1932x1932px: 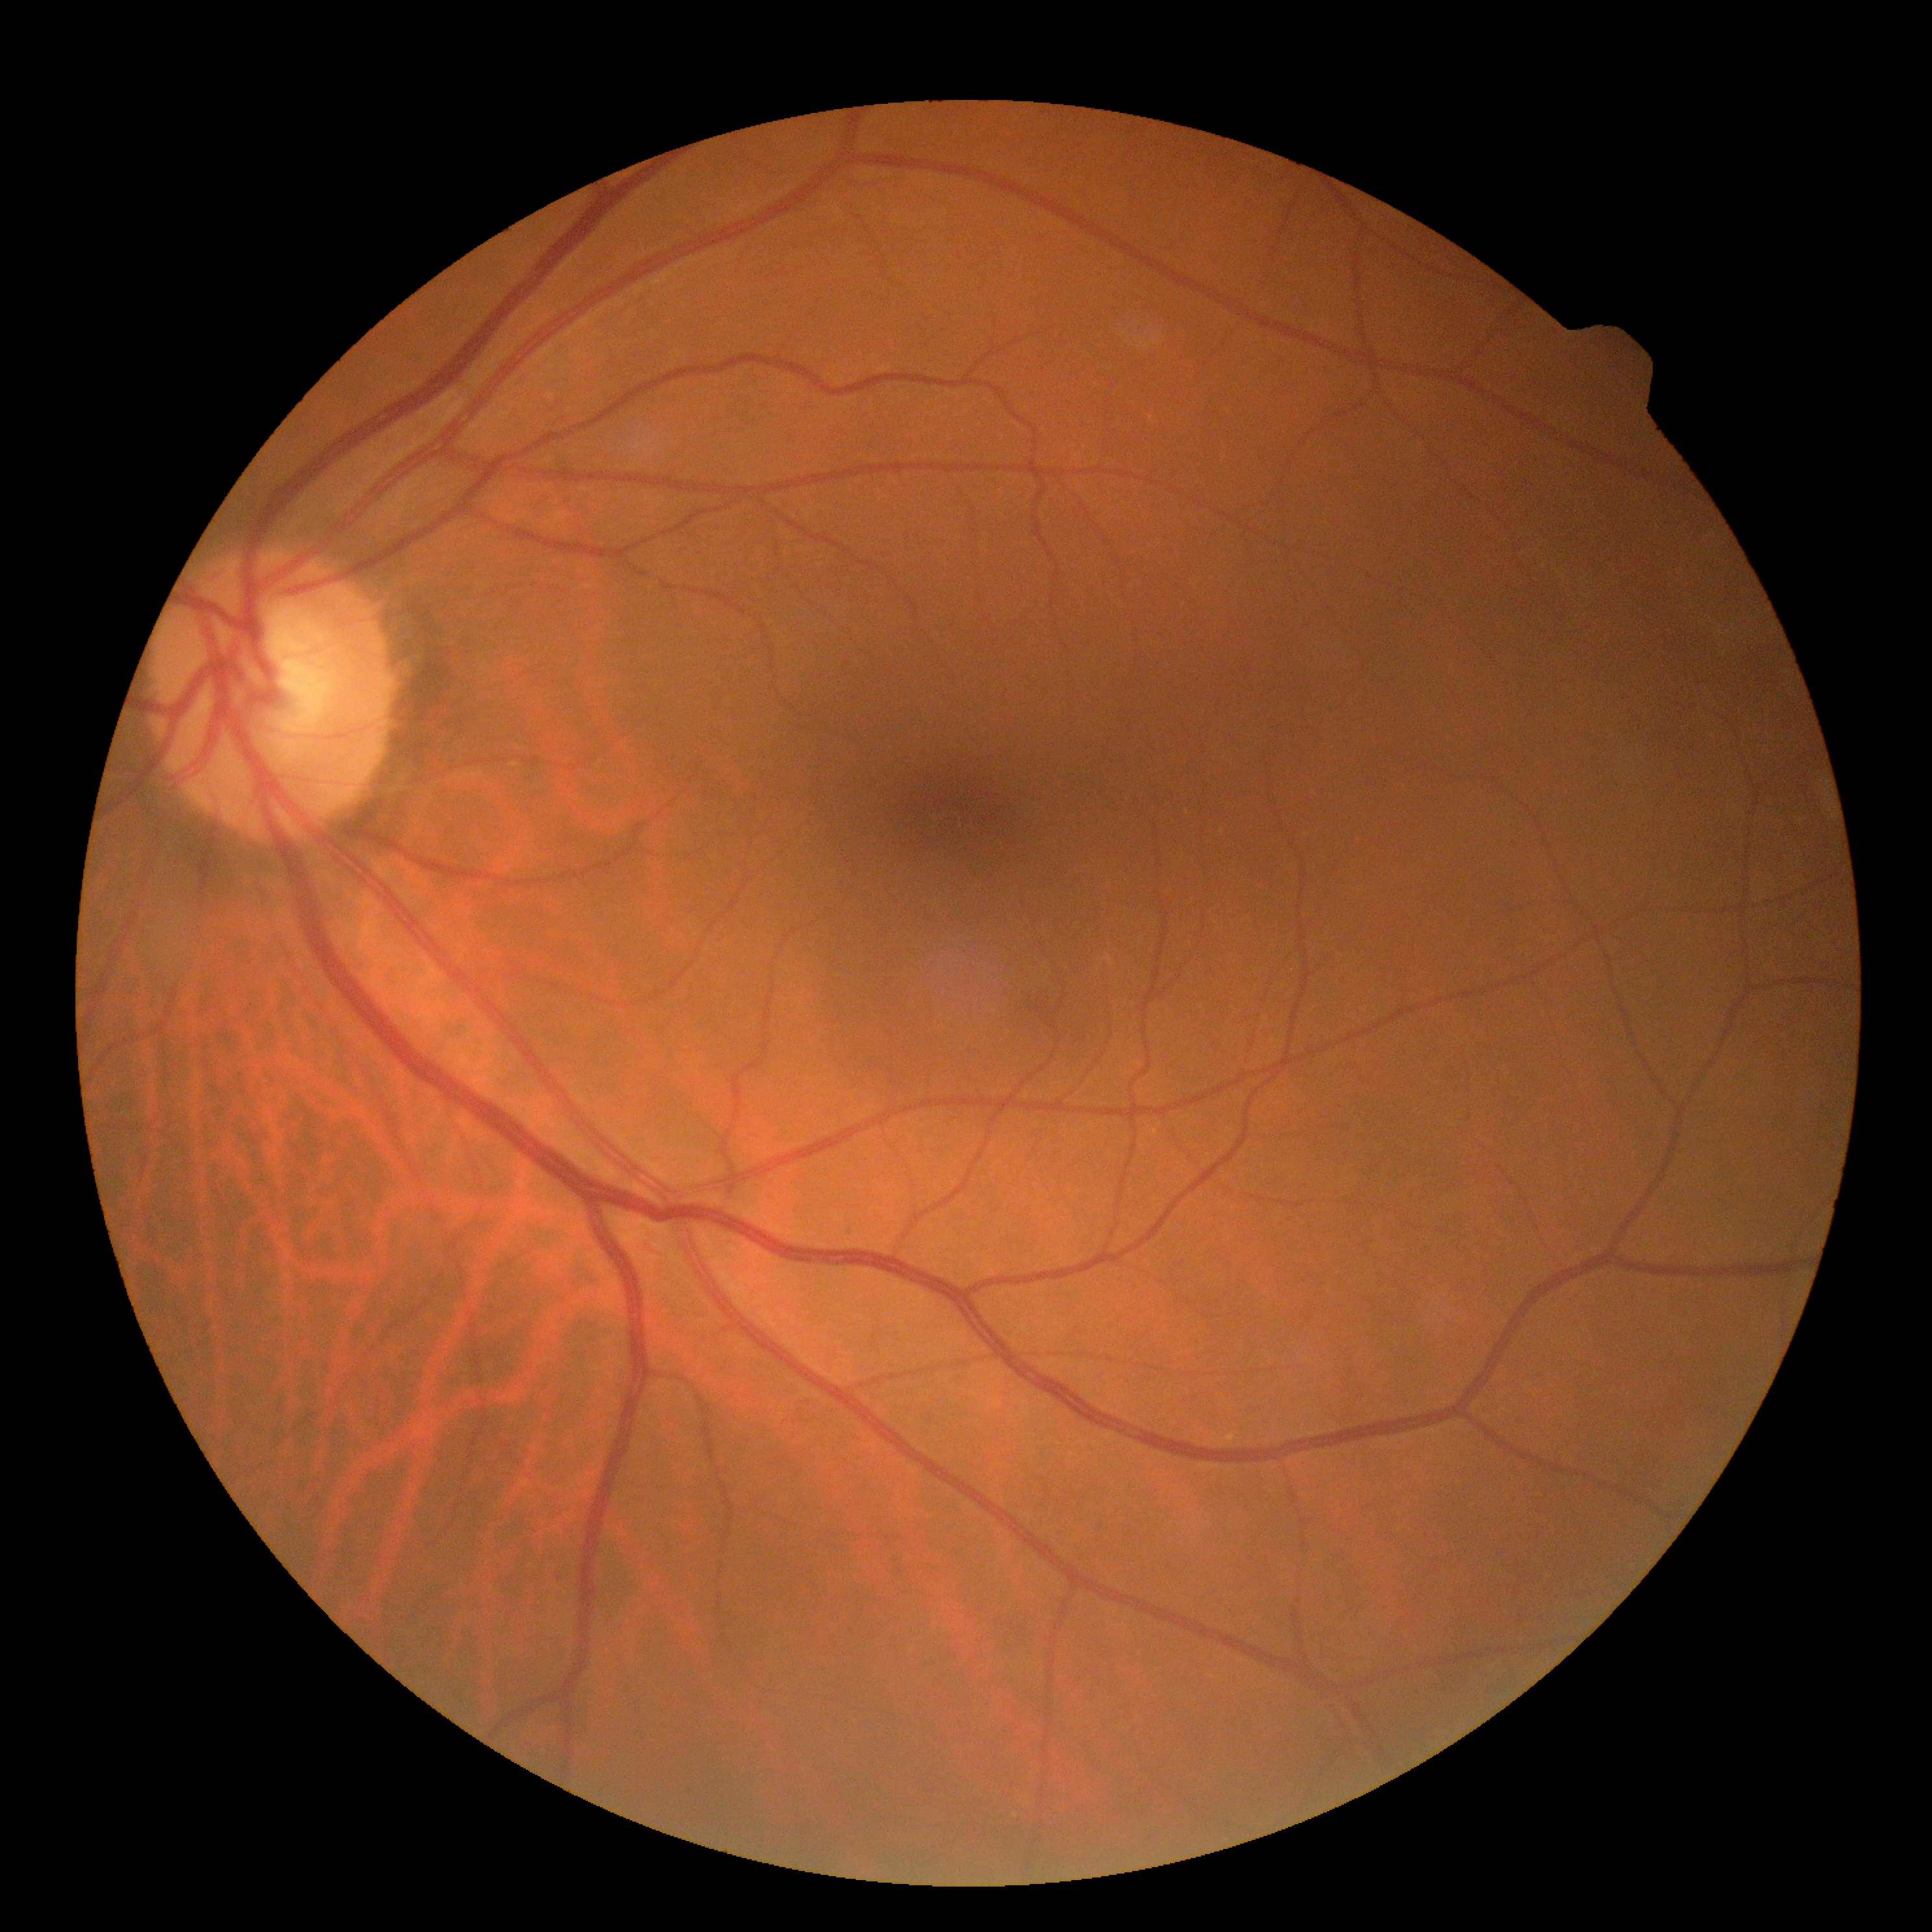
Annotations:
* DR severity — 0